NIDEK AFC-230 fundus camera; 45 degree fundus photograph; nonmydriatic fundus photograph — 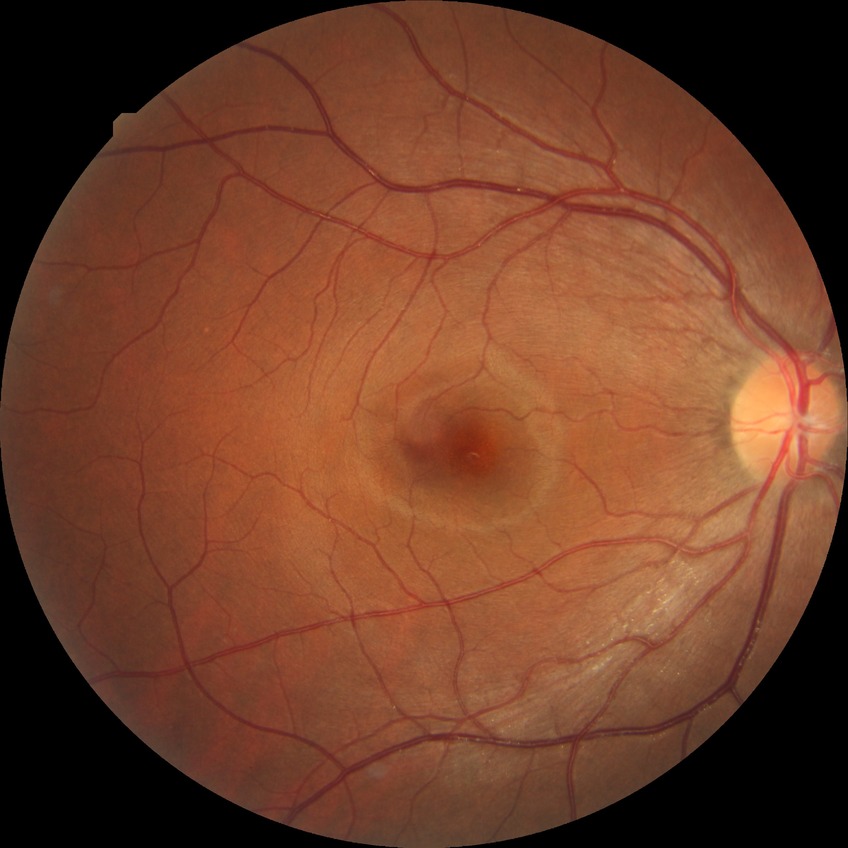

{"davis_grade": "no diabetic retinopathy"}